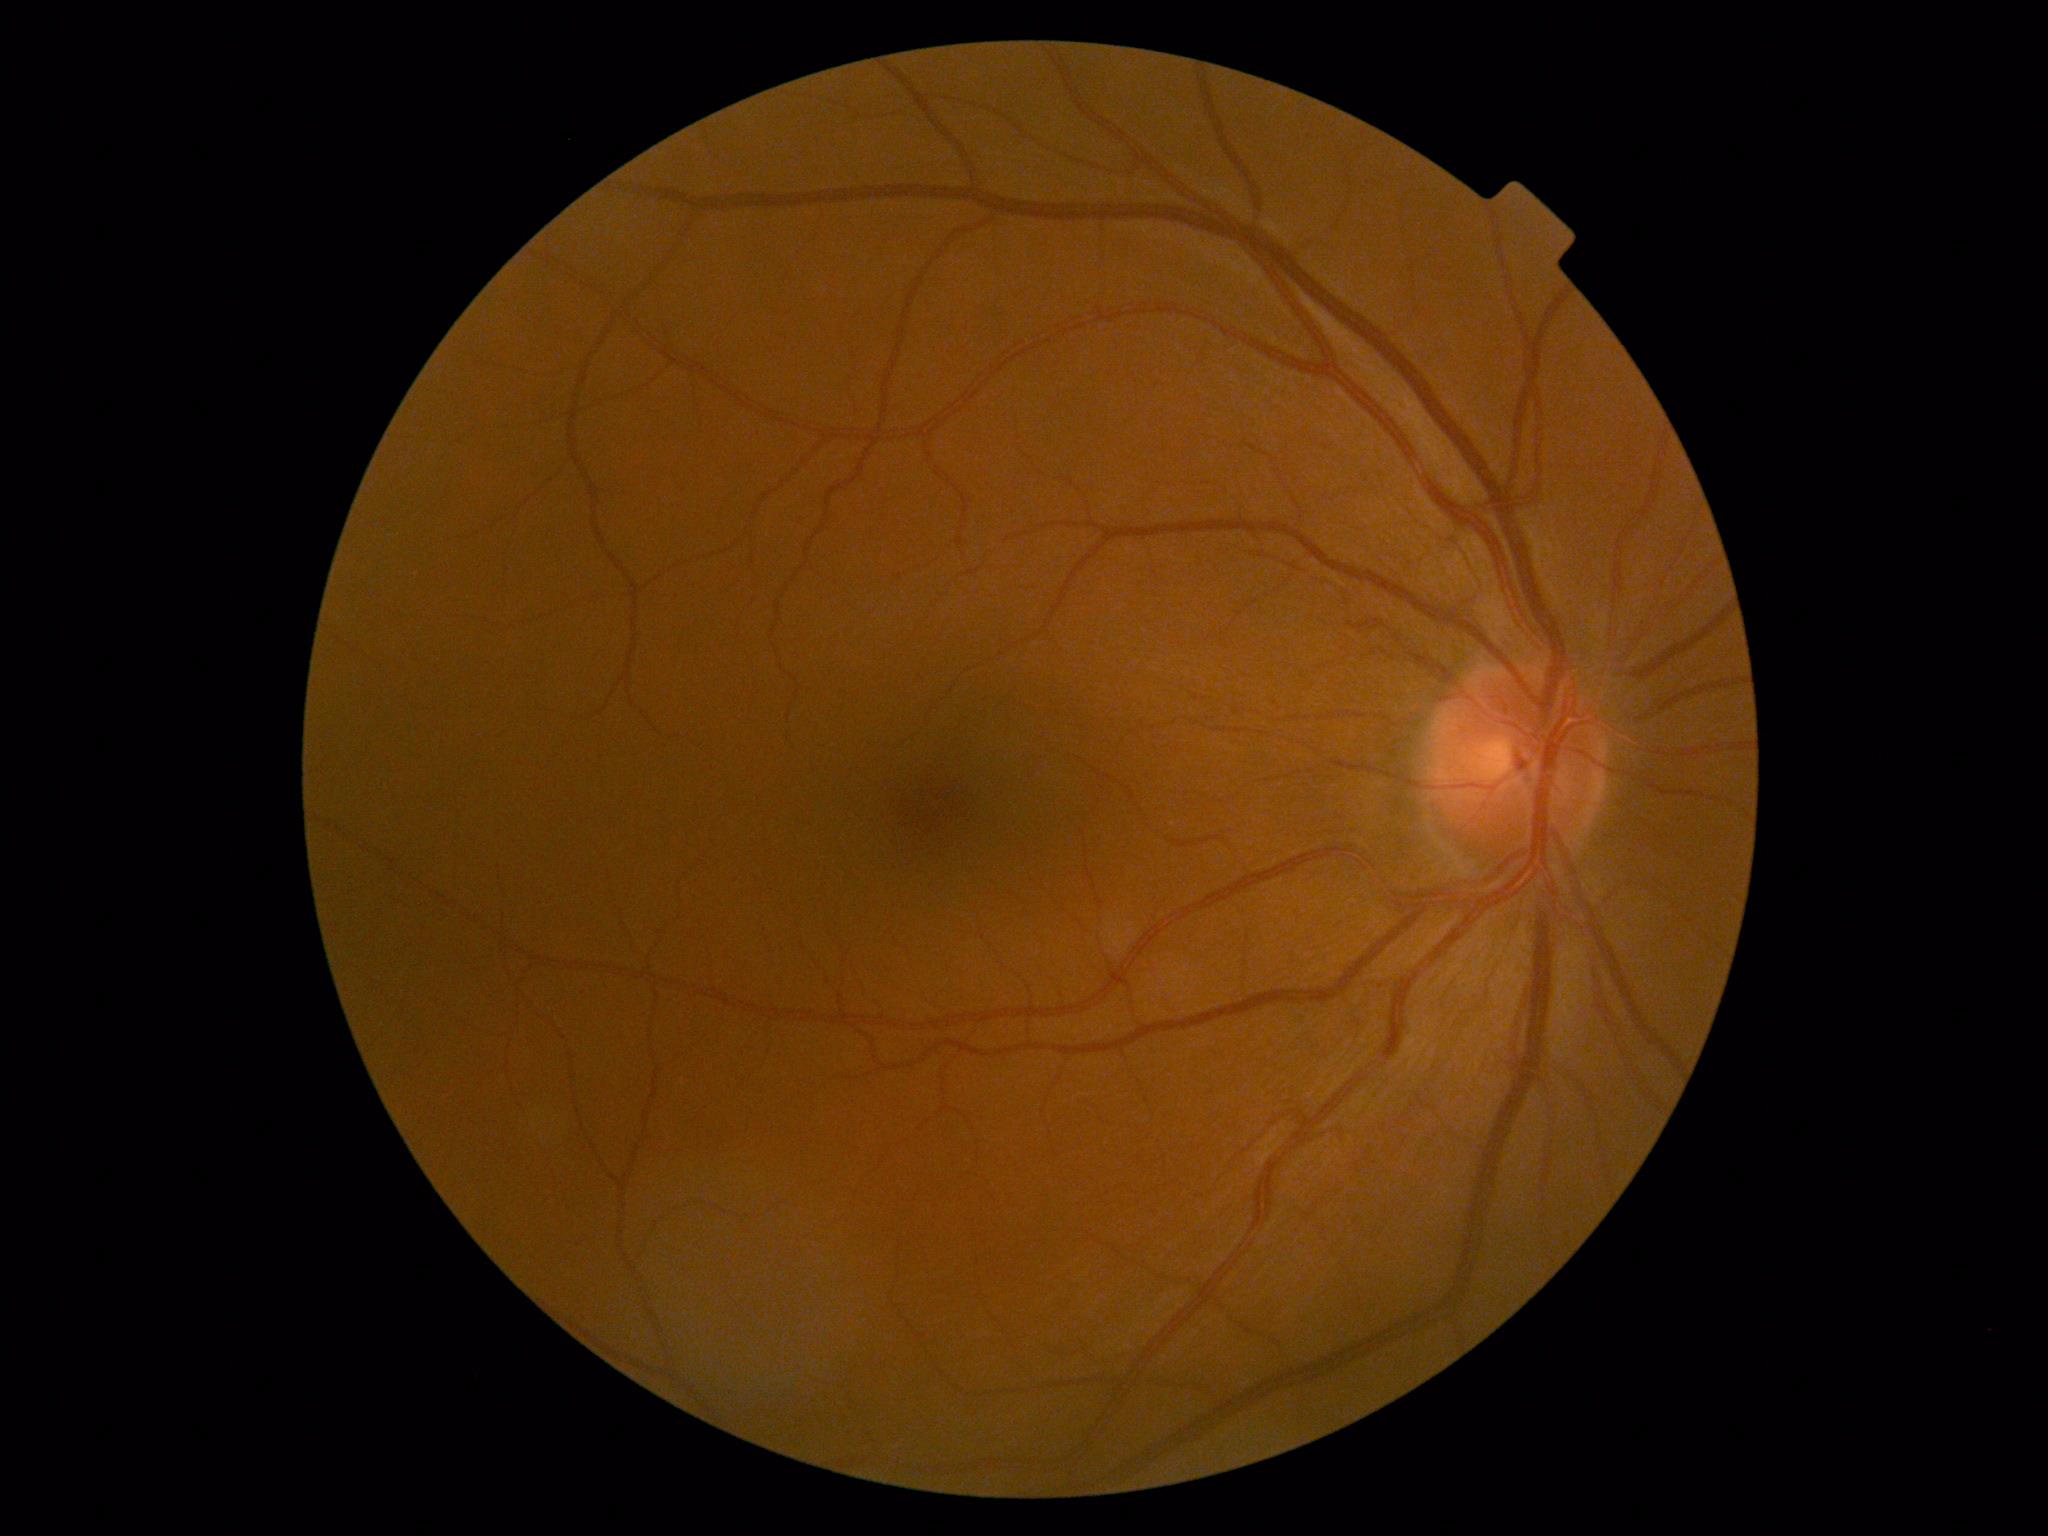 diabetic retinopathy severity@0.